FOV: 45 degrees · fundus photo
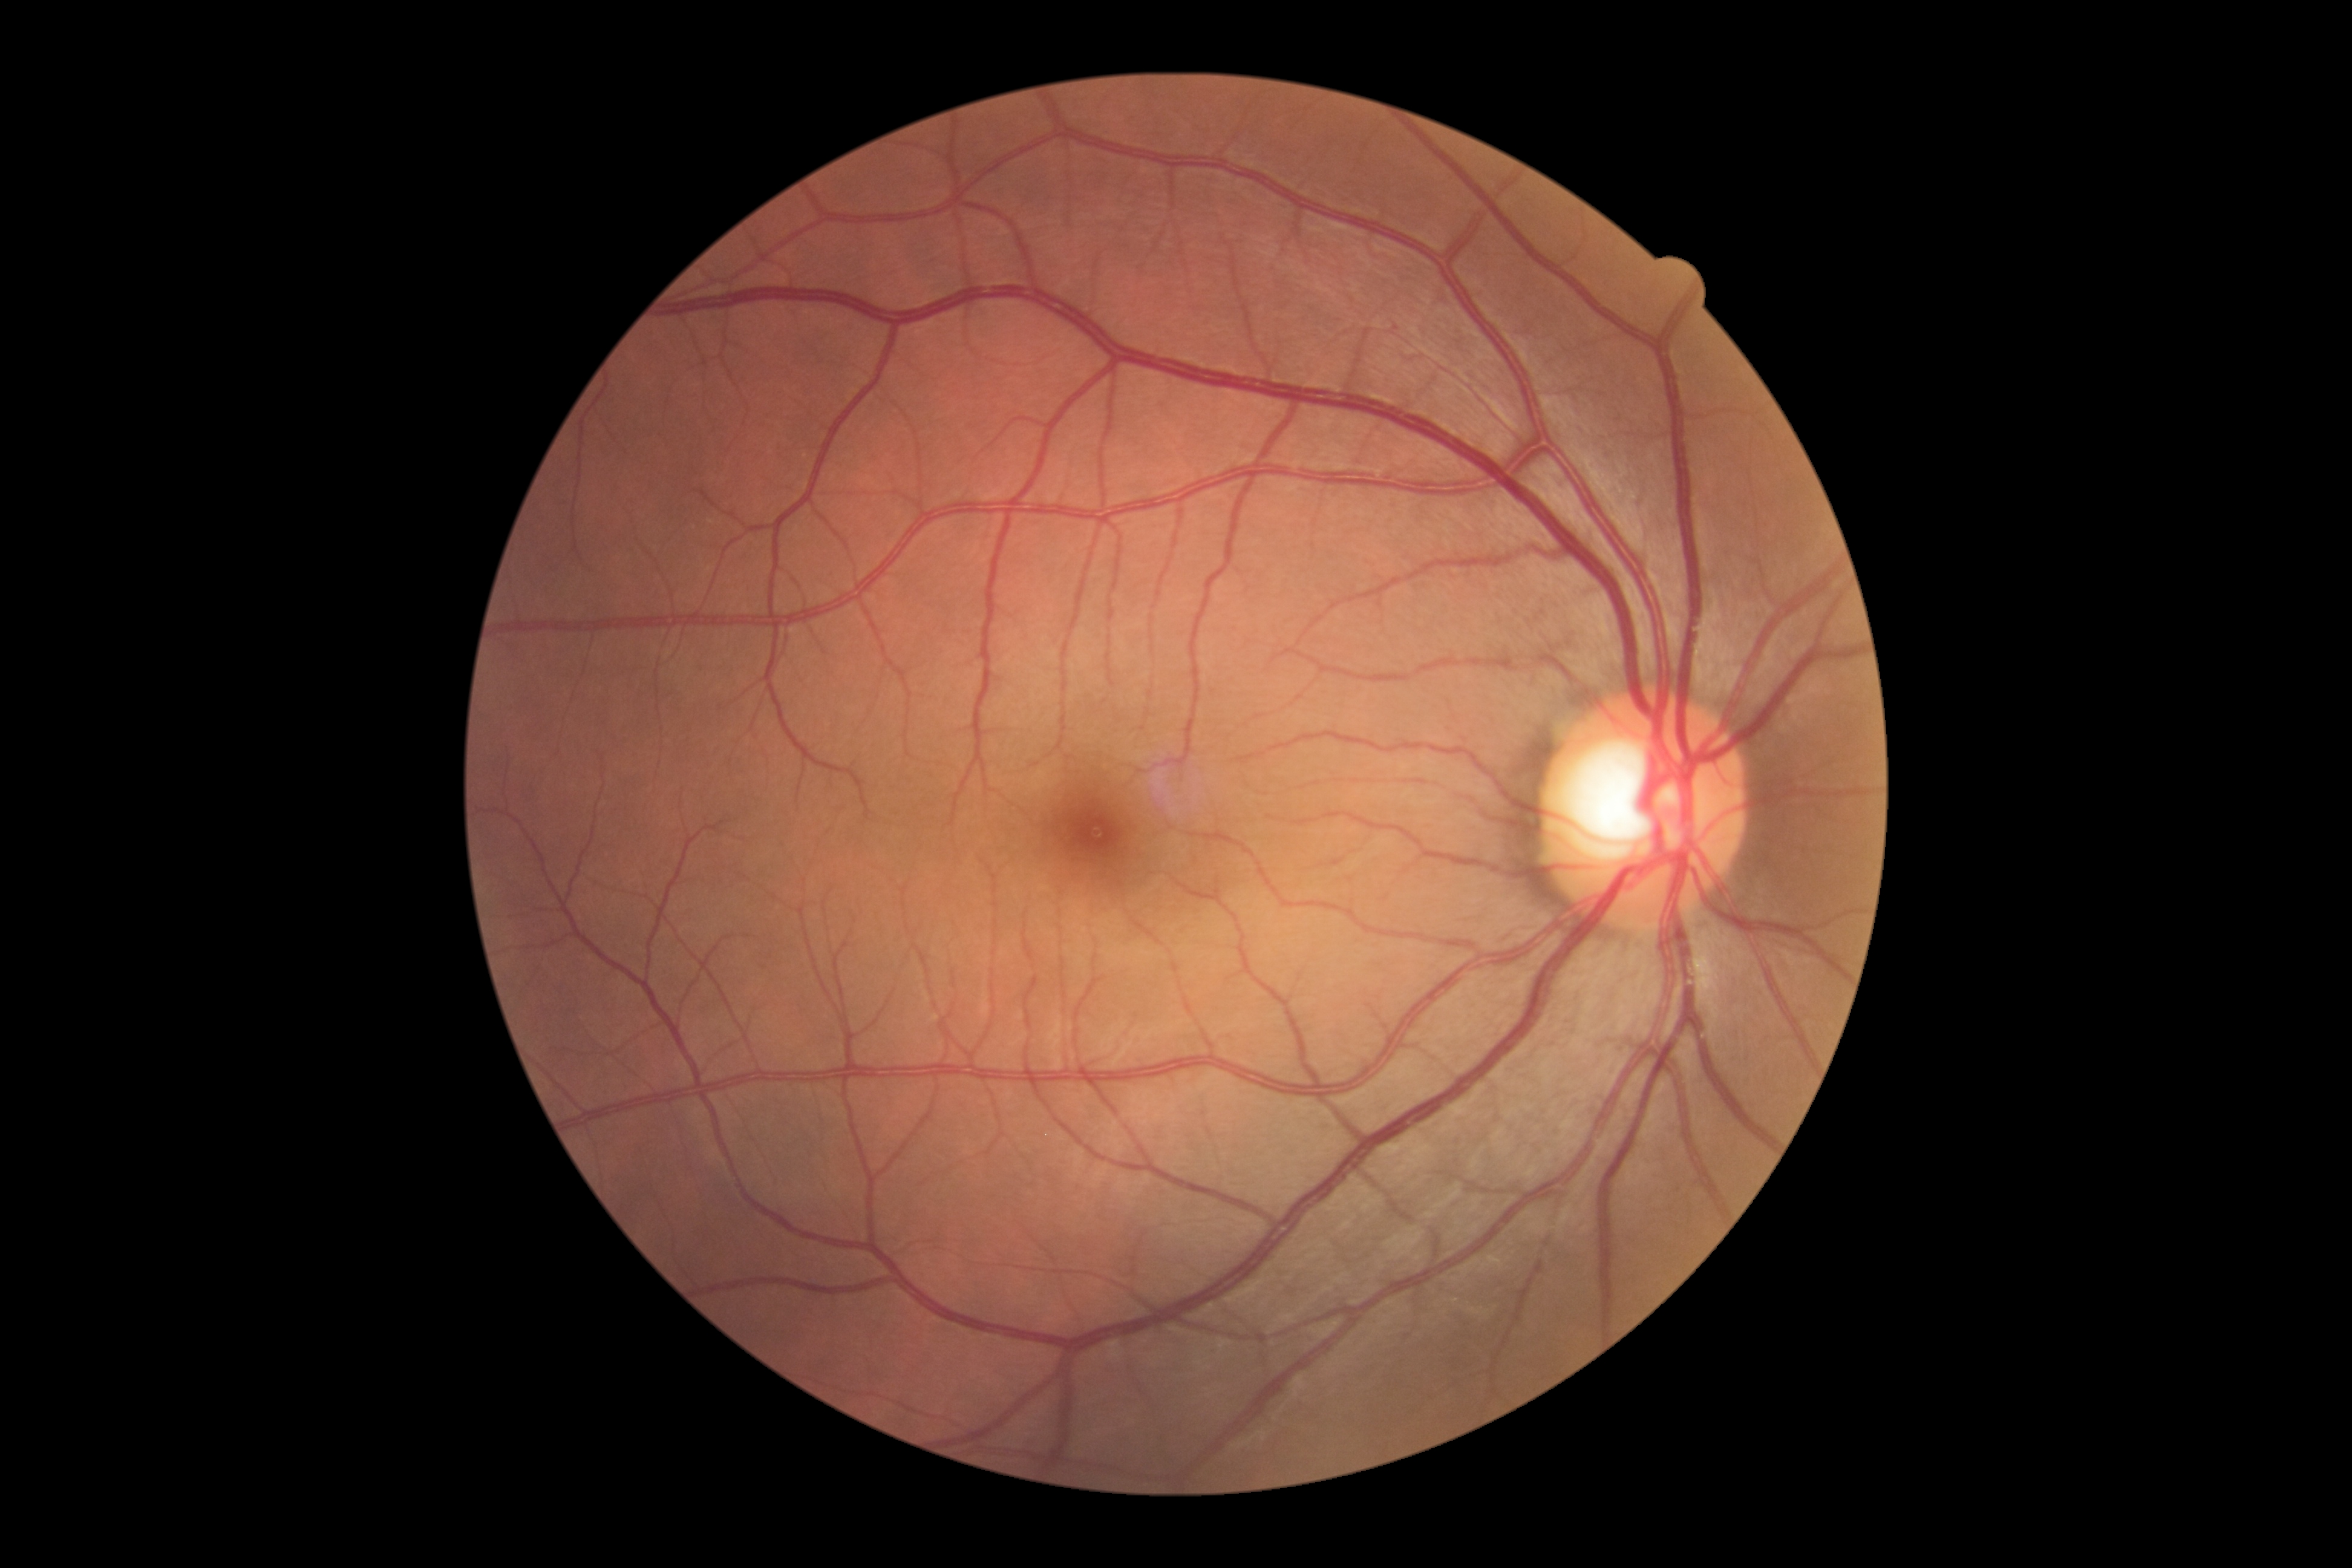 Diabetic retinopathy (DR): 0/4 — no visible signs of diabetic retinopathy.